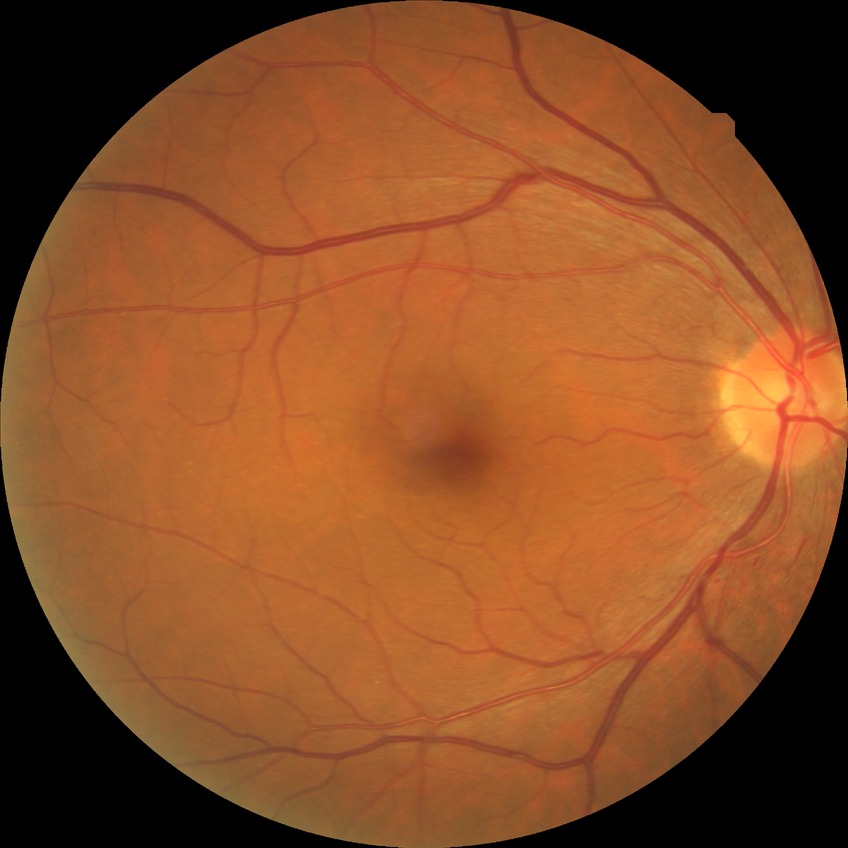

diabetic retinopathy (DR): NDR (no diabetic retinopathy).